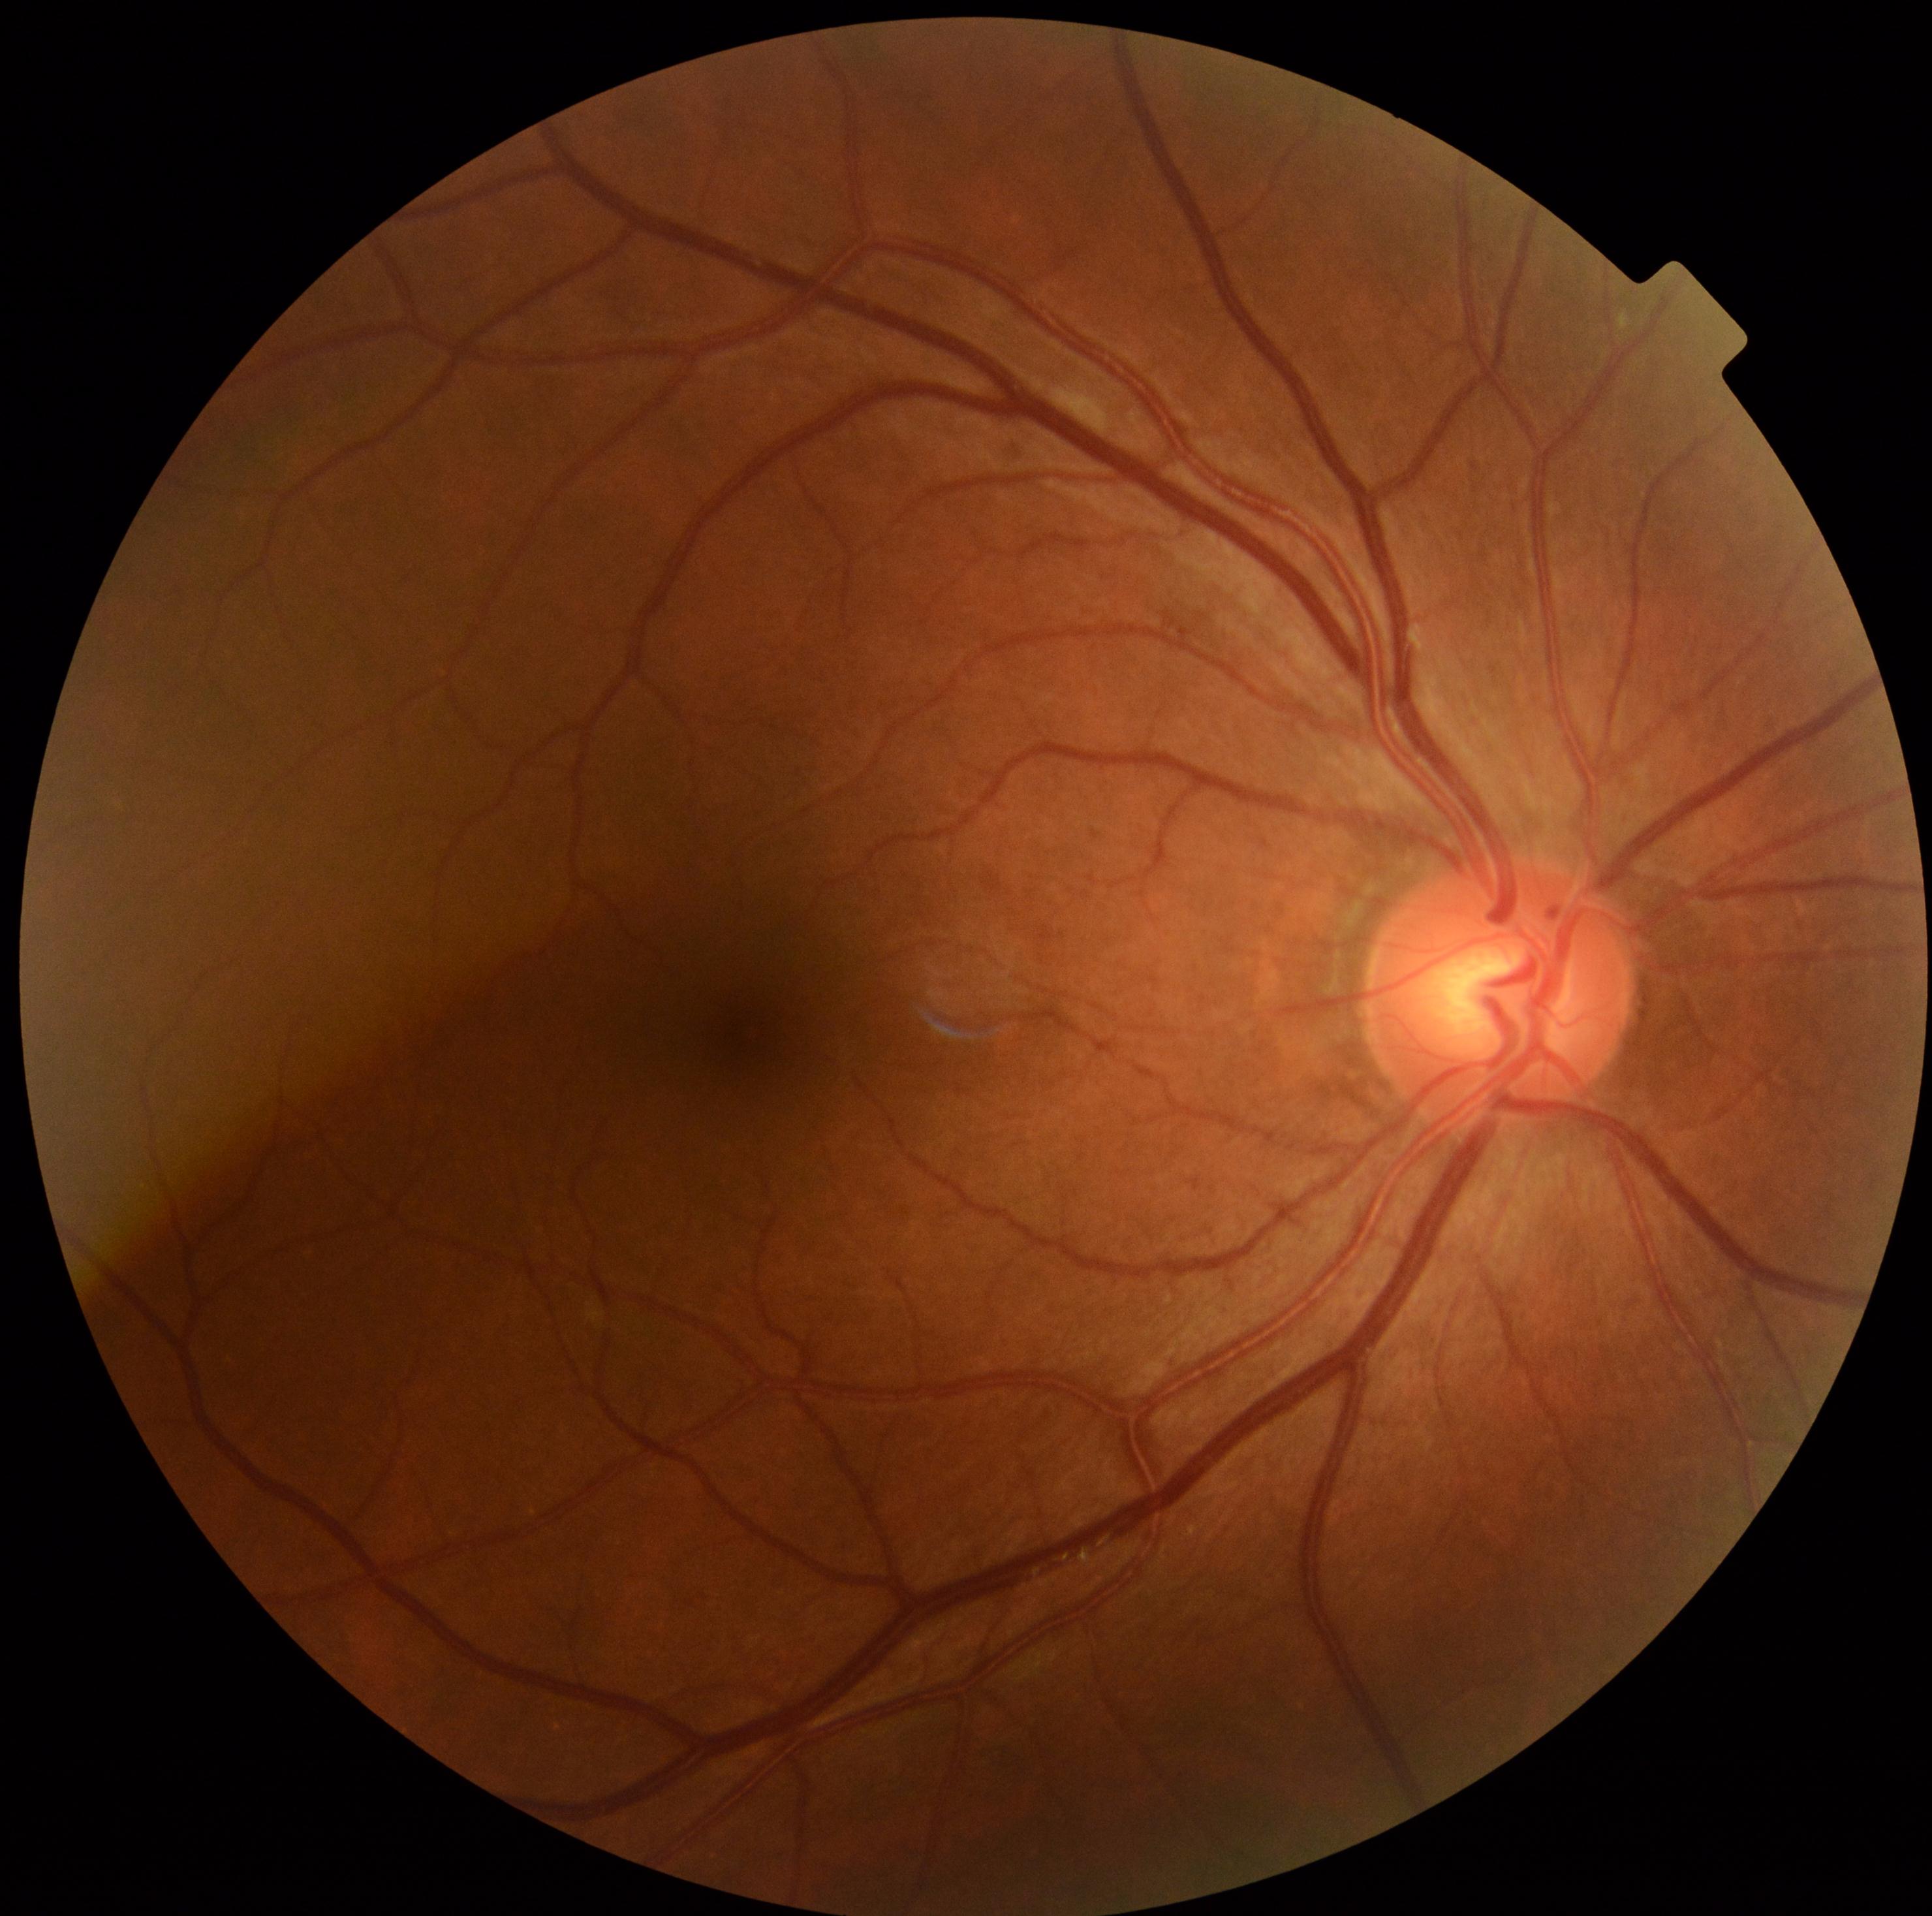
DR is 0 — no visible signs of diabetic retinopathy.